Color fundus photograph: 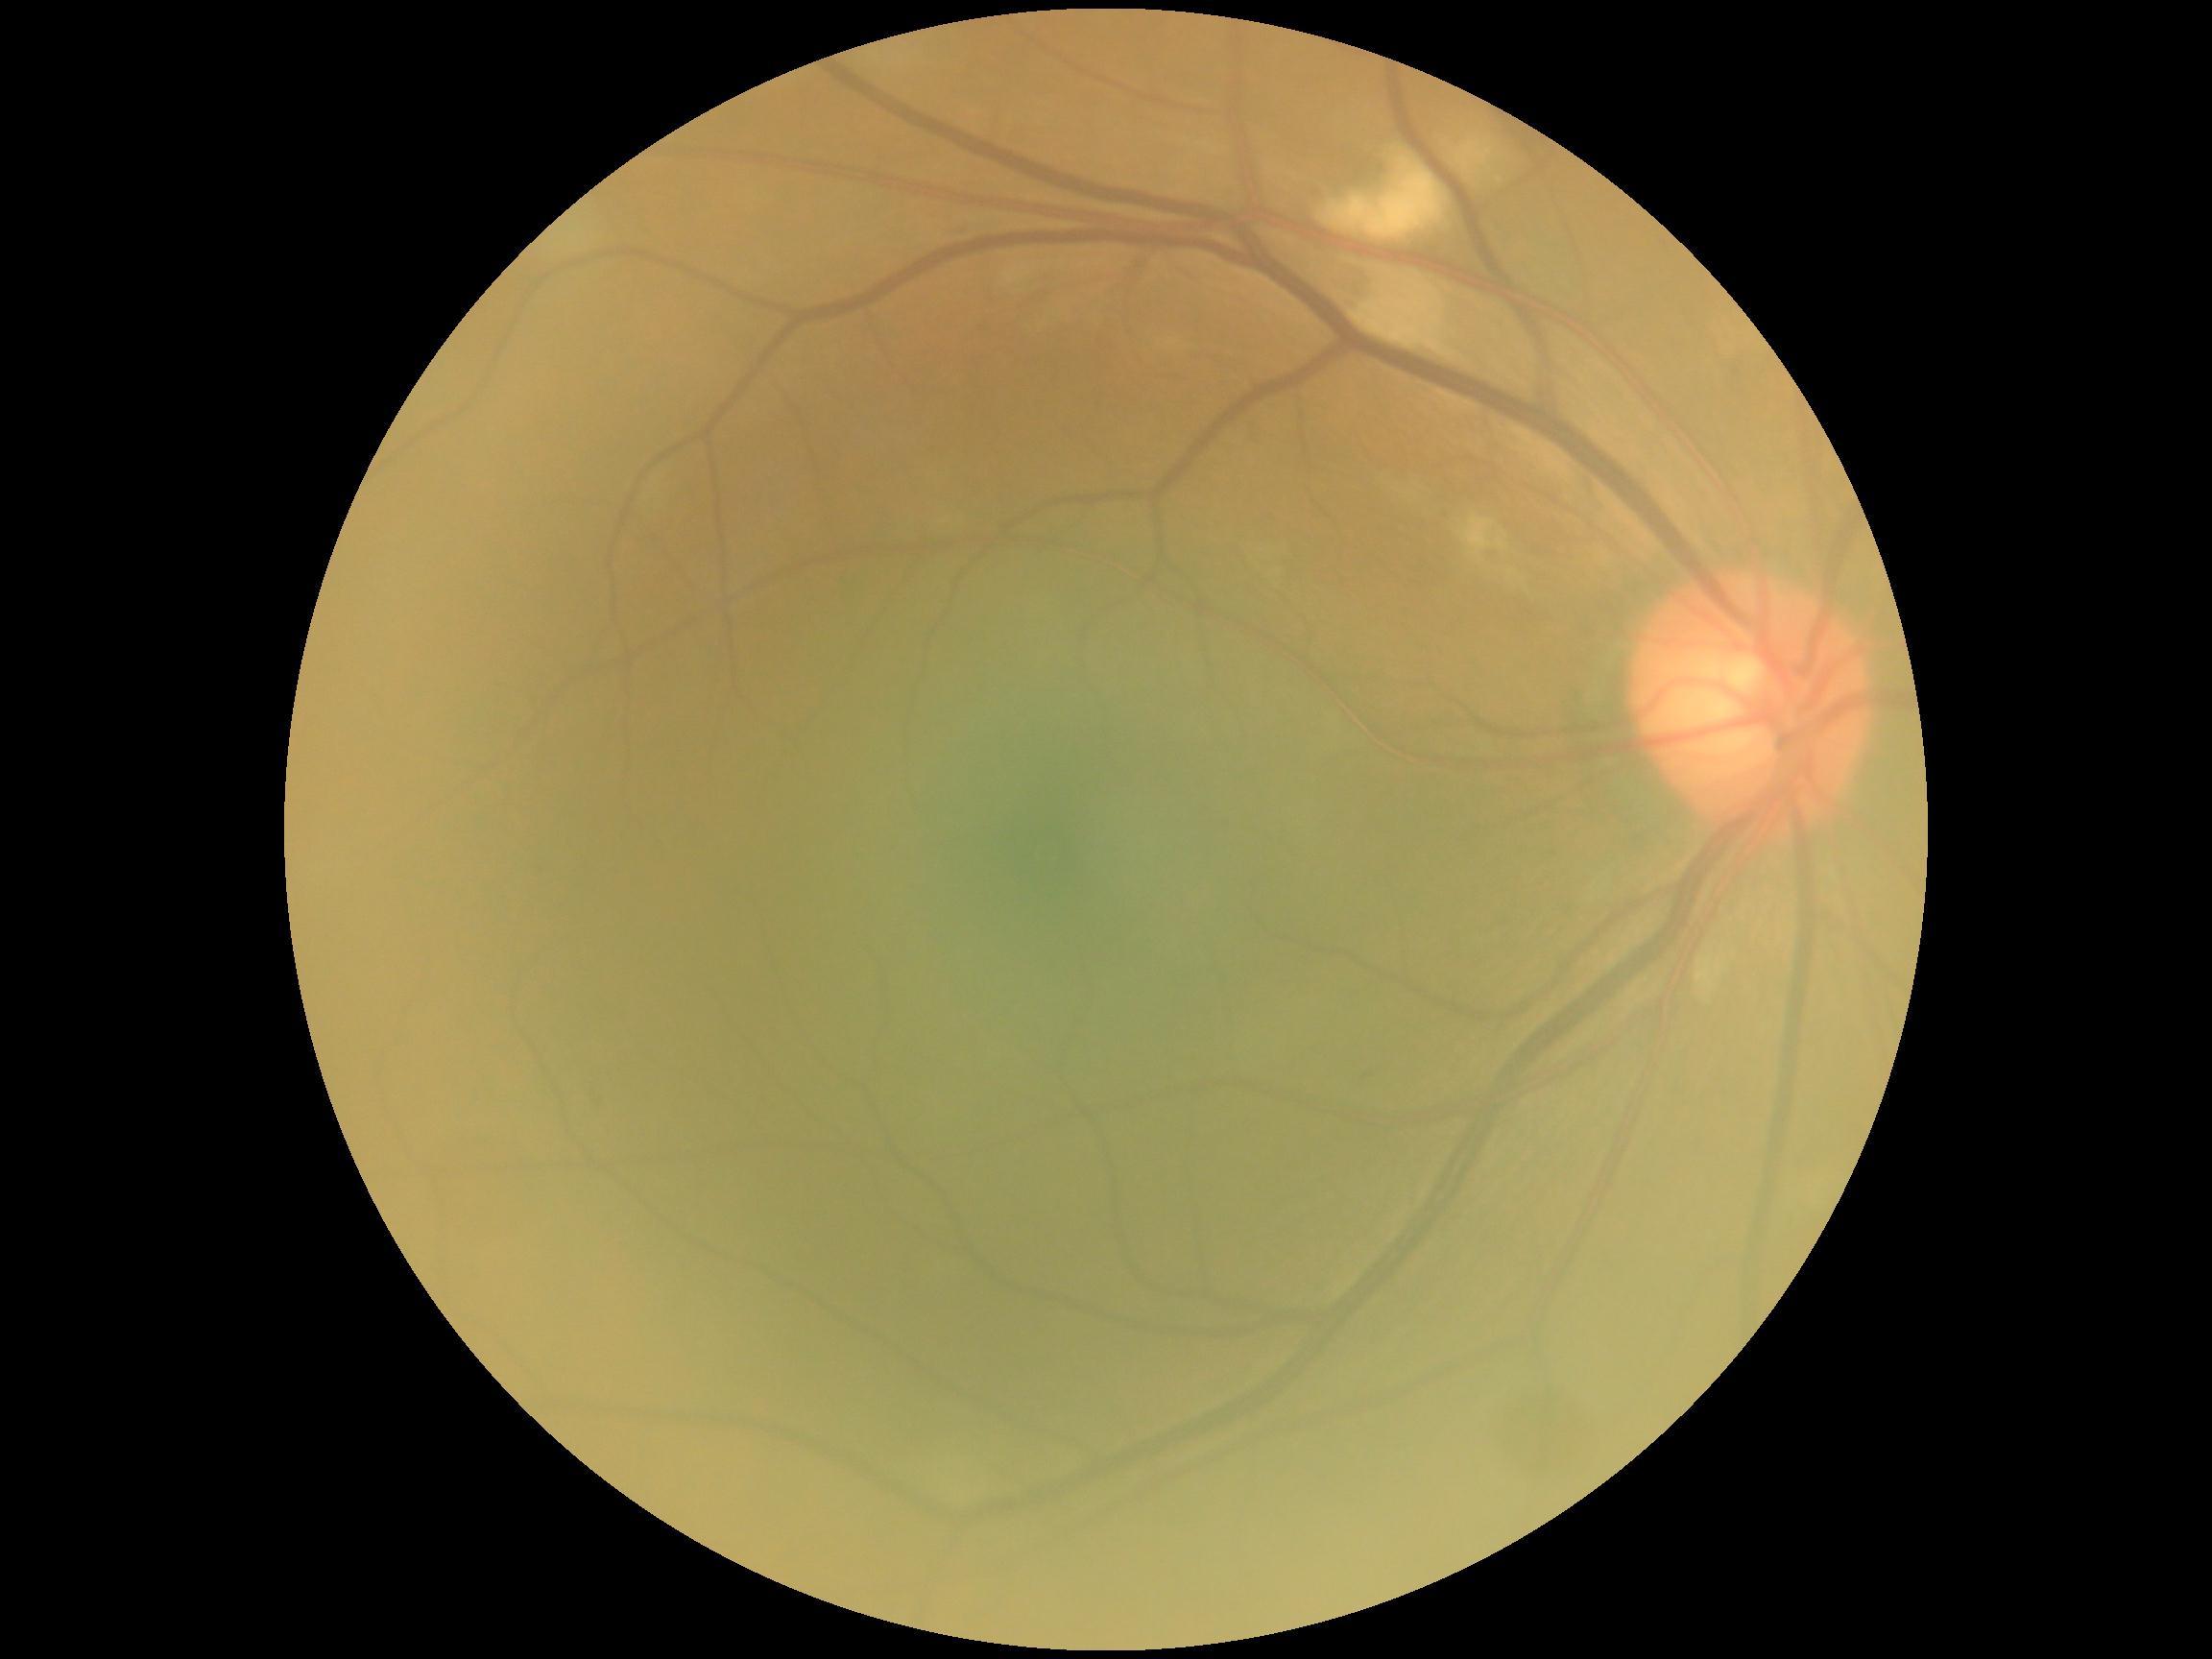
DR class: non-proliferative diabetic retinopathy; diabetic retinopathy (DR): grade 2 (moderate NPDR).